Modified Davis grading: 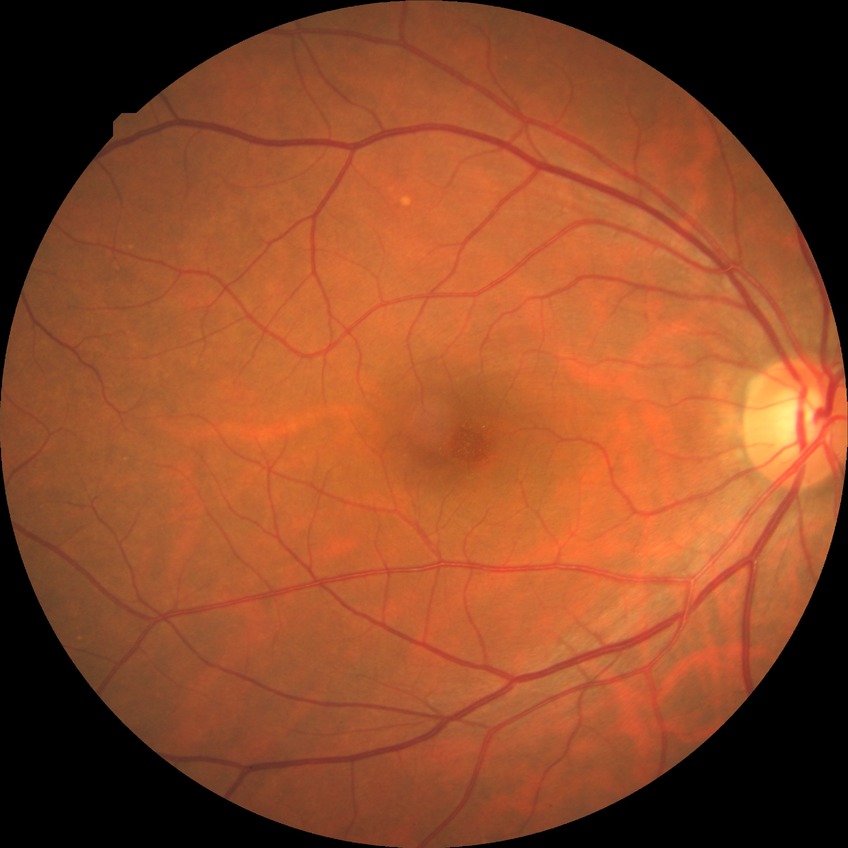

Diabetic retinopathy (DR): no diabetic retinopathy (NDR).